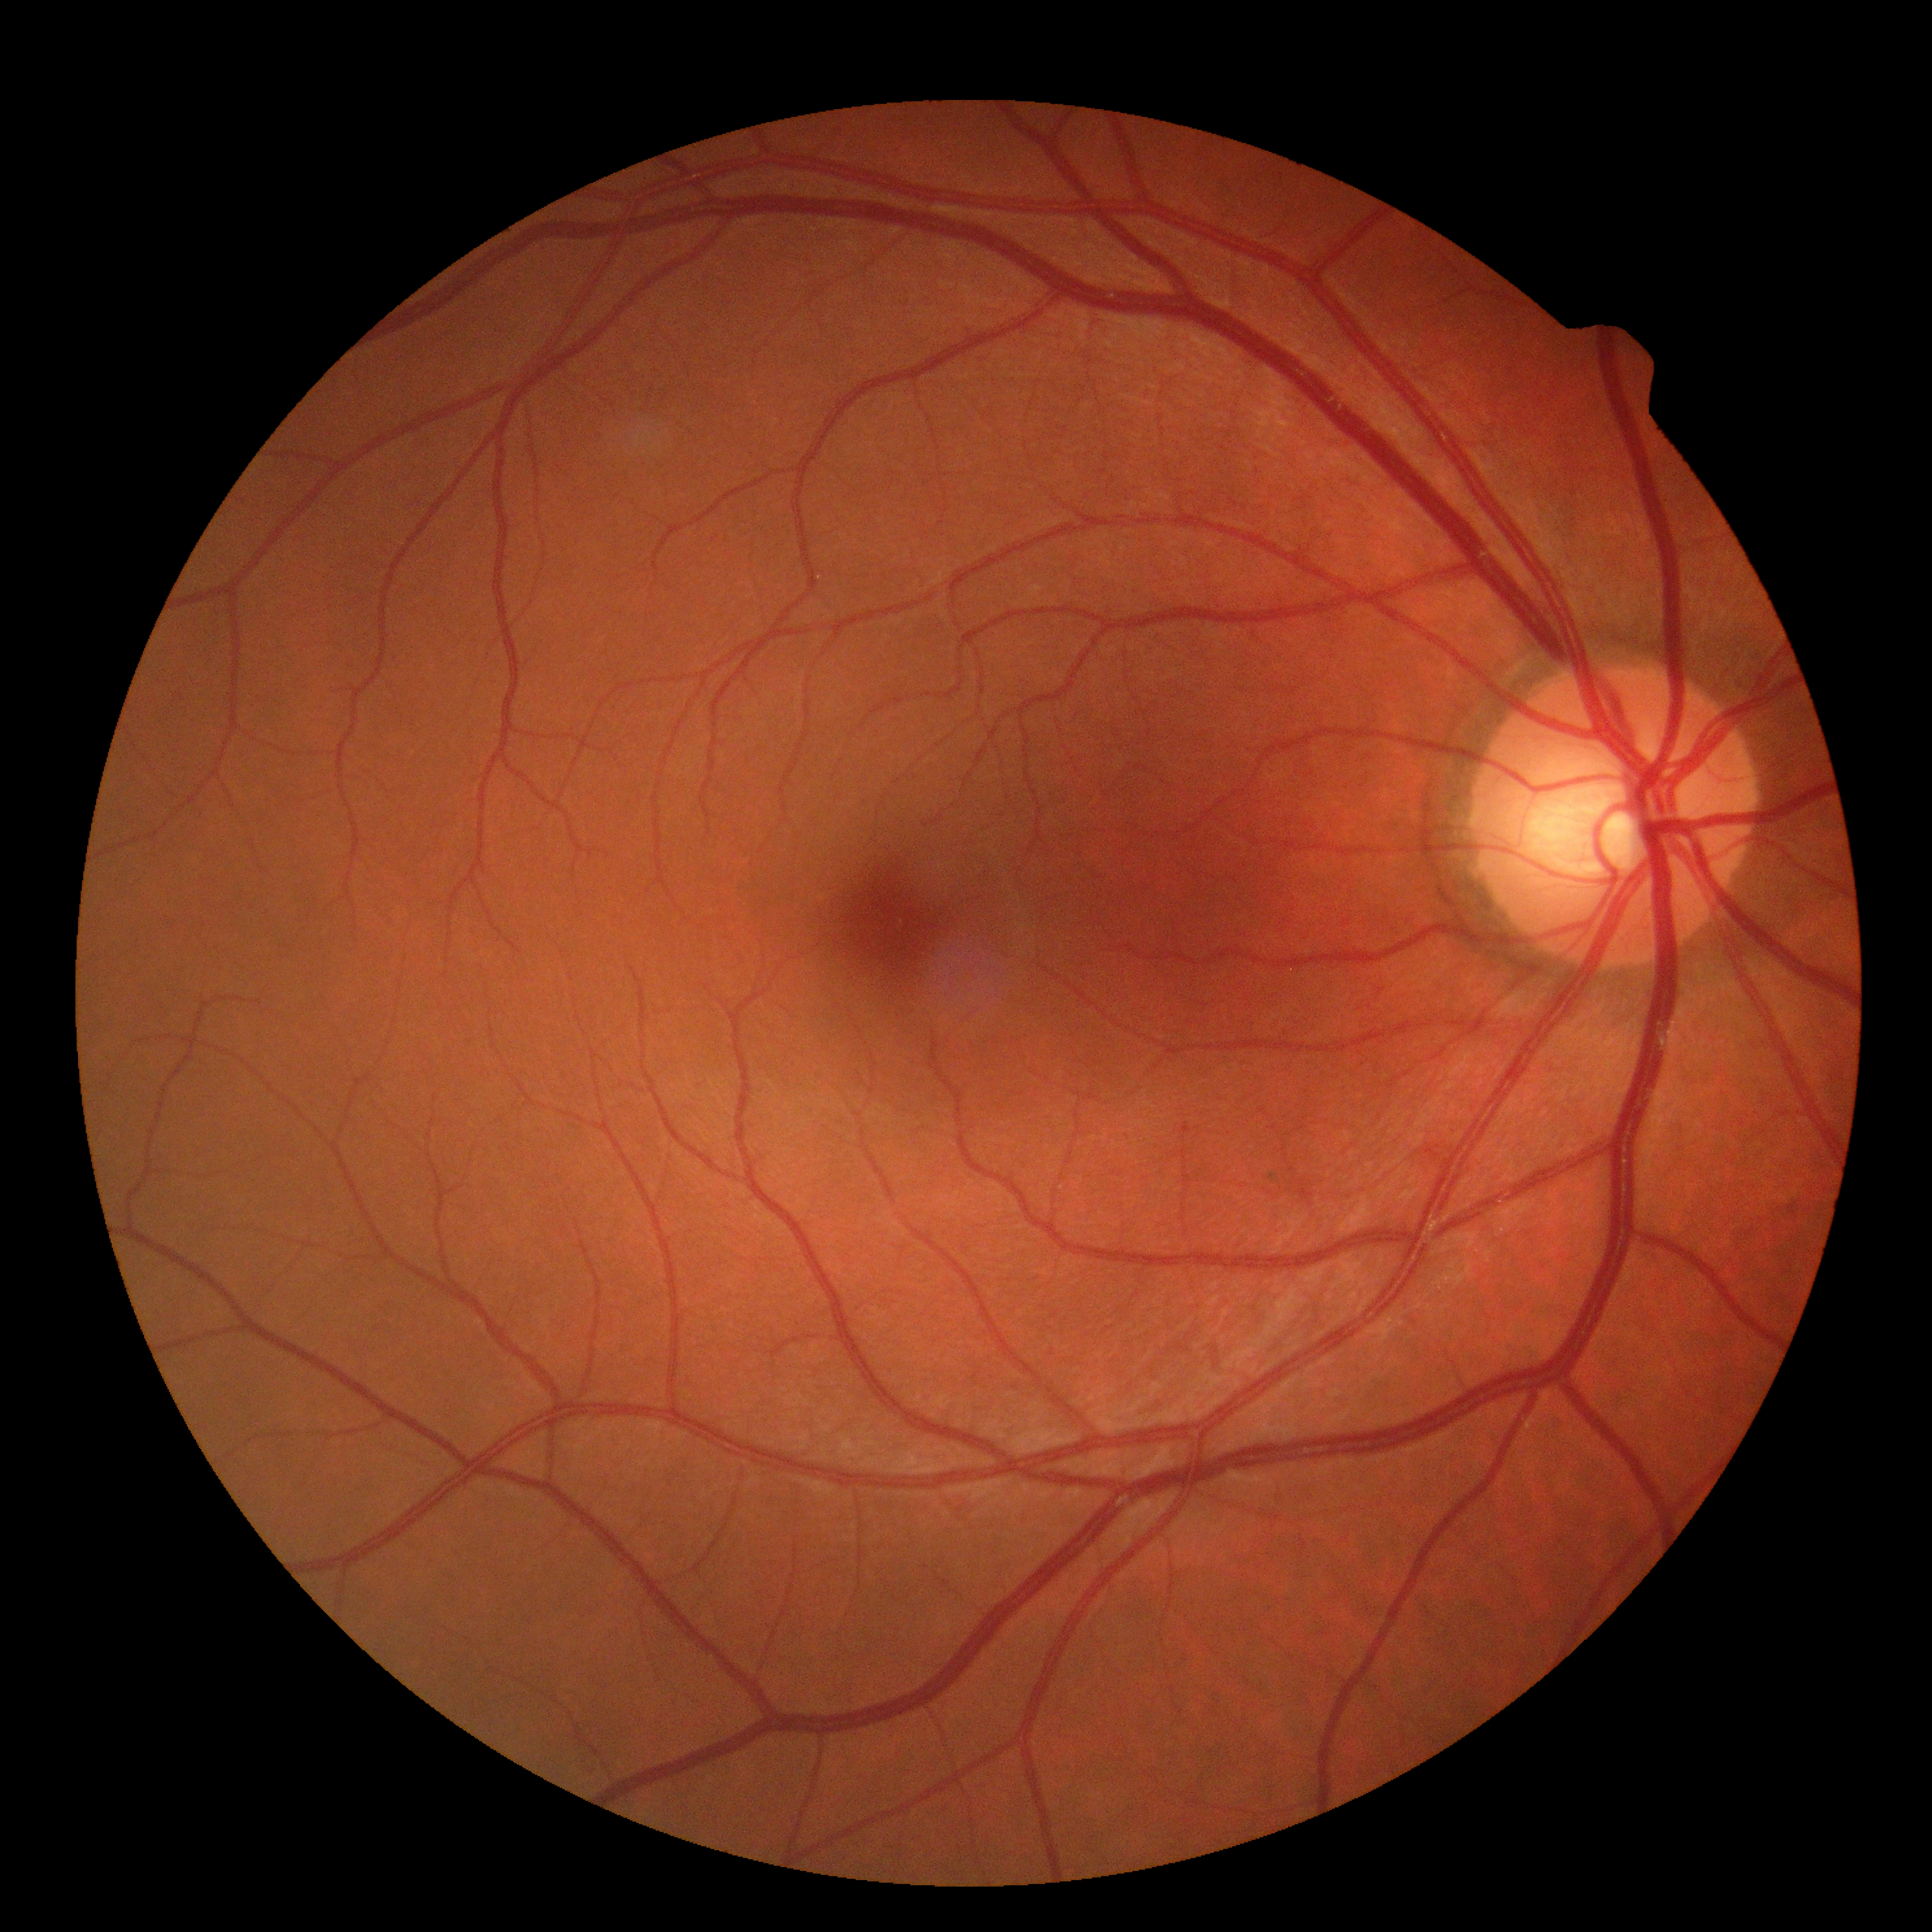 {"dr_grade": "grade 0"}